Nonmydriatic. Acquired with a NIDEK AFC-230 — 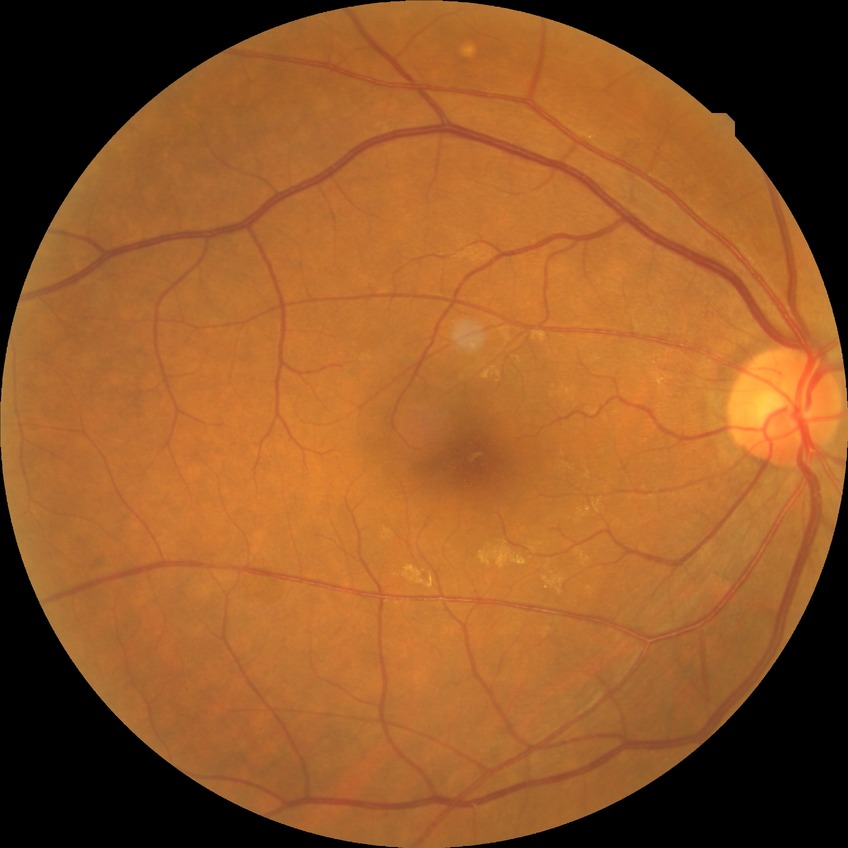 Diabetic retinopathy (DR): no diabetic retinopathy (NDR).